FOV: 45 degrees. NIDEK AFC-230. Without pupil dilation:
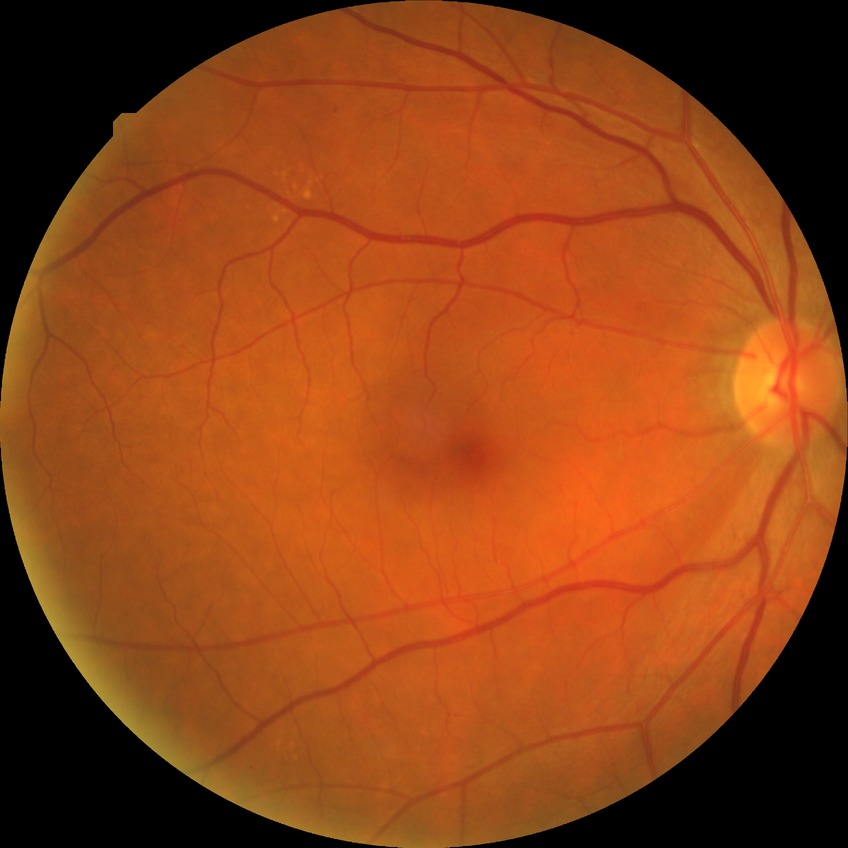

retinopathy grade@pre-proliferative diabetic retinopathy, DR class@non-proliferative diabetic retinopathy.